Macula at the center of the field; acquired with a Topcon TRC-NW8.
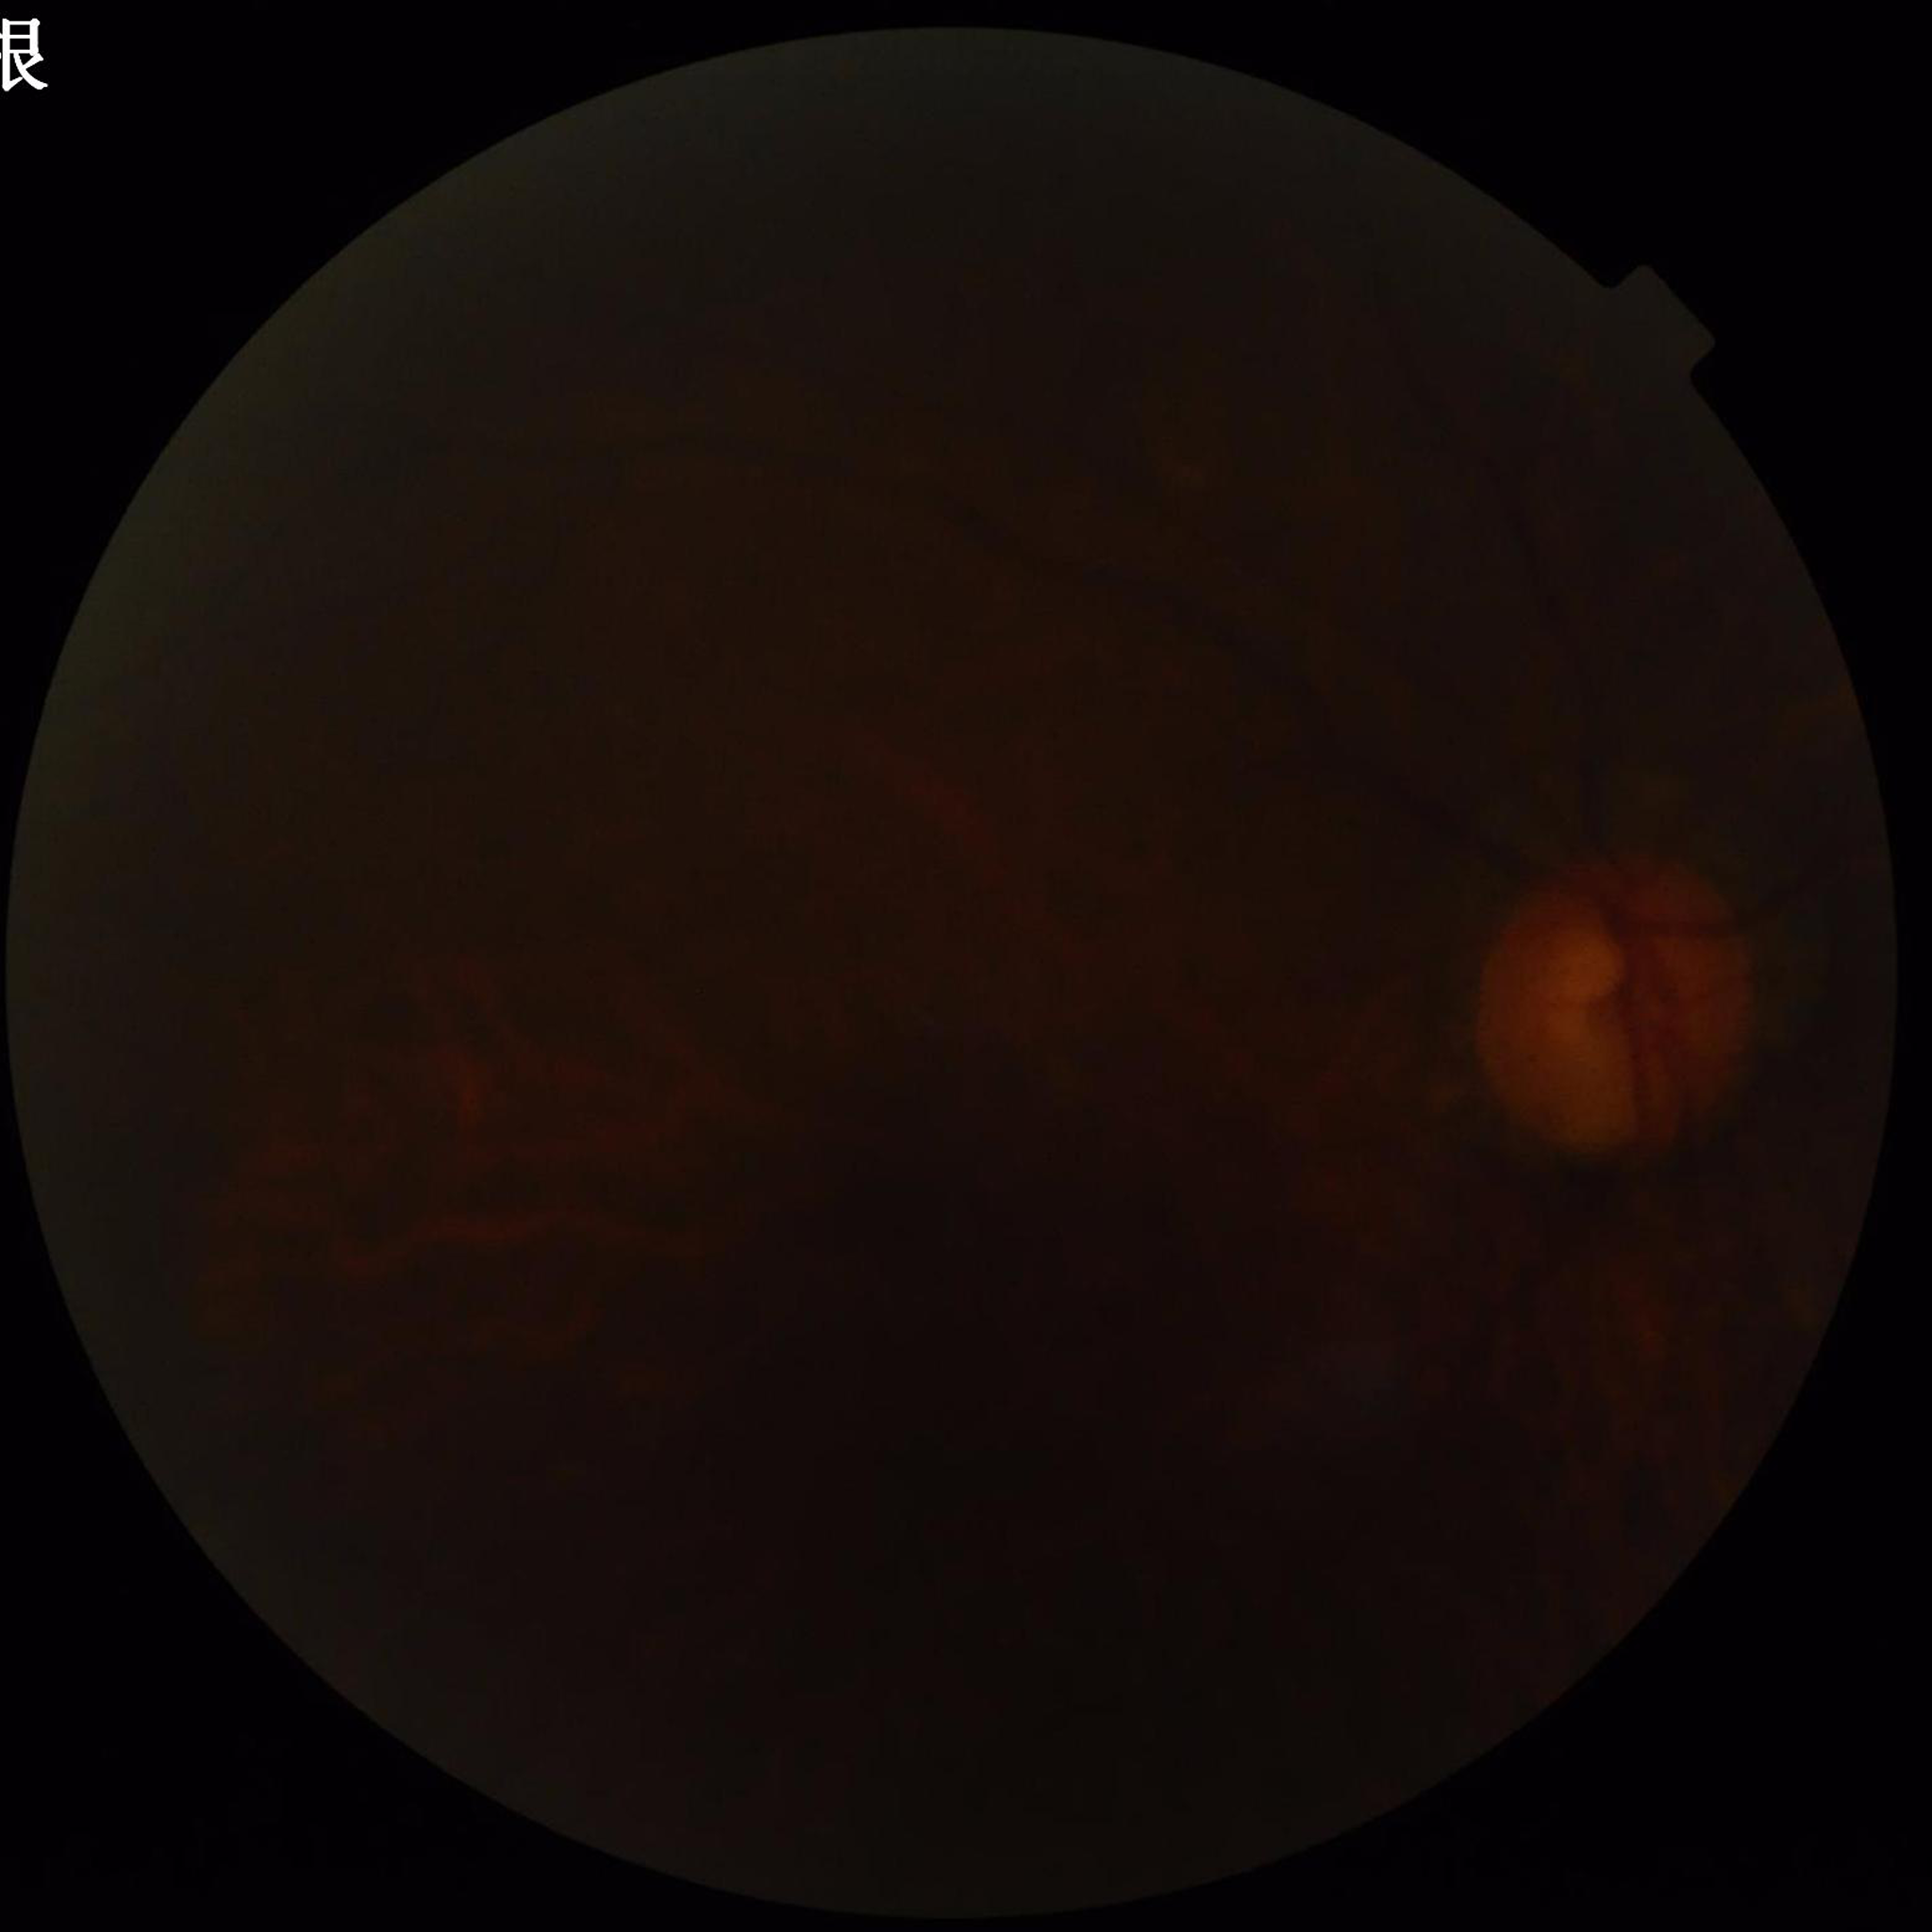

Diagnosed with glaucoma.